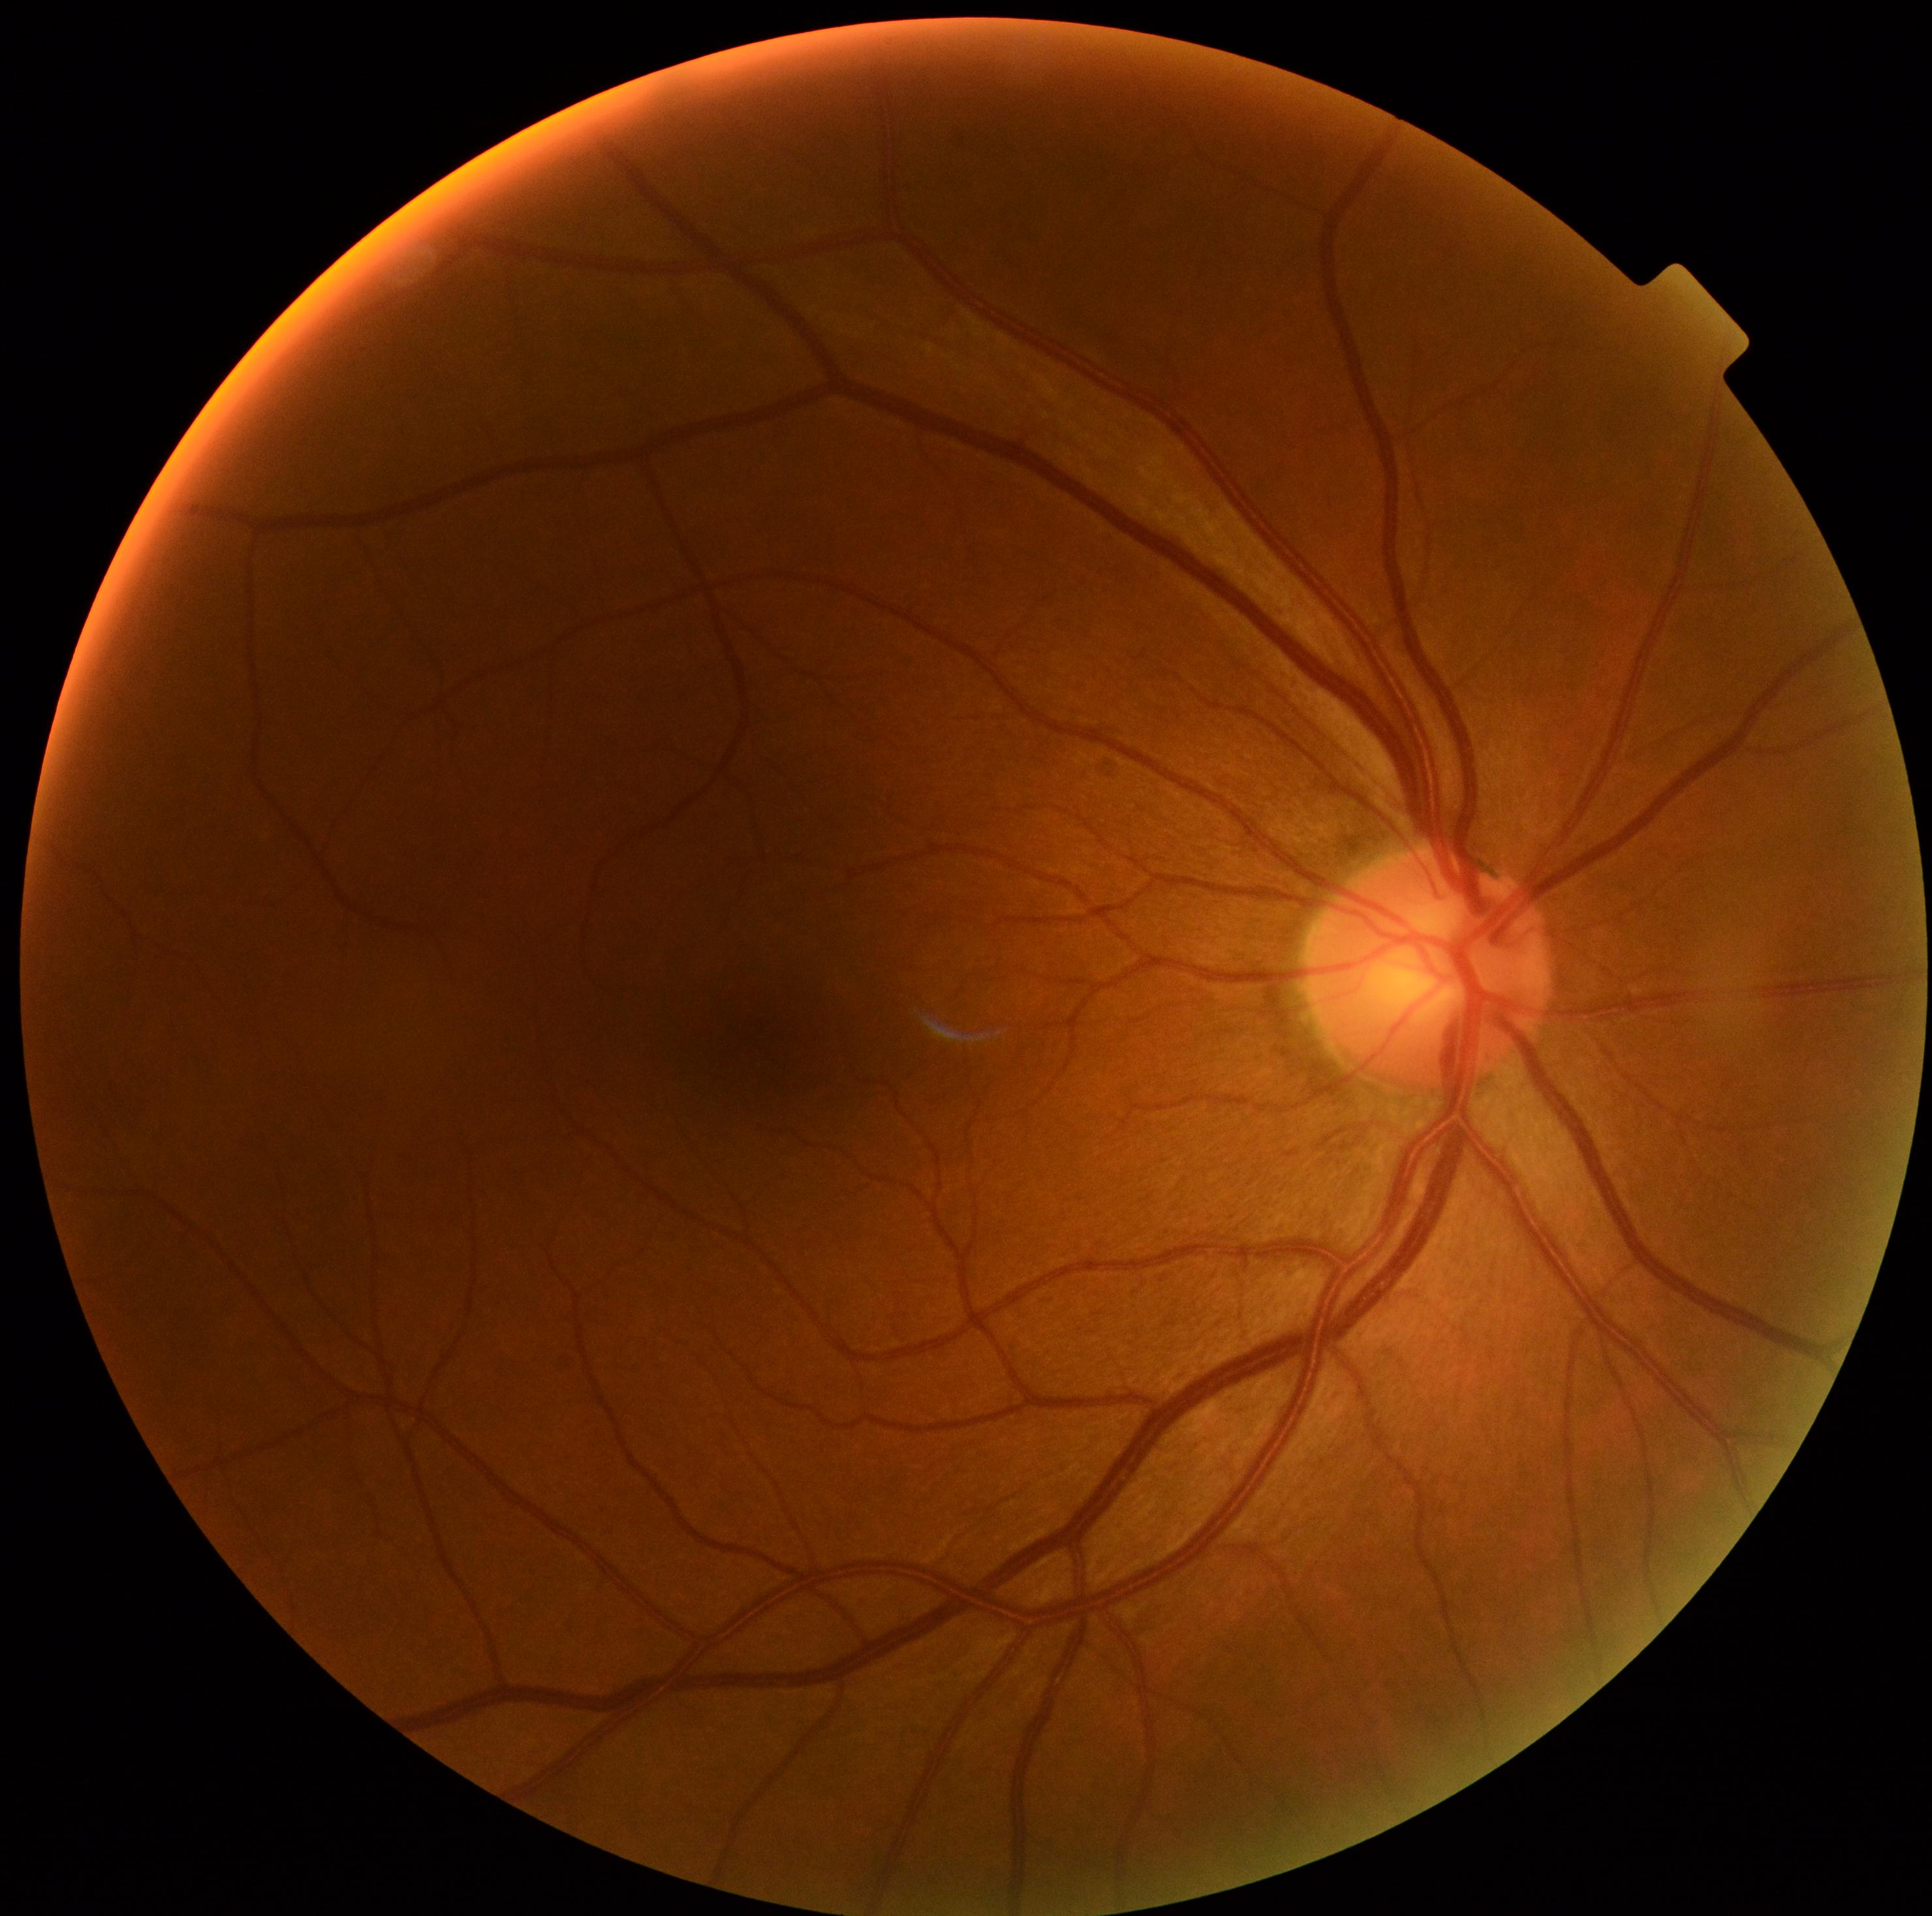
DR=no apparent diabetic retinopathy (grade 0).